Color fundus image
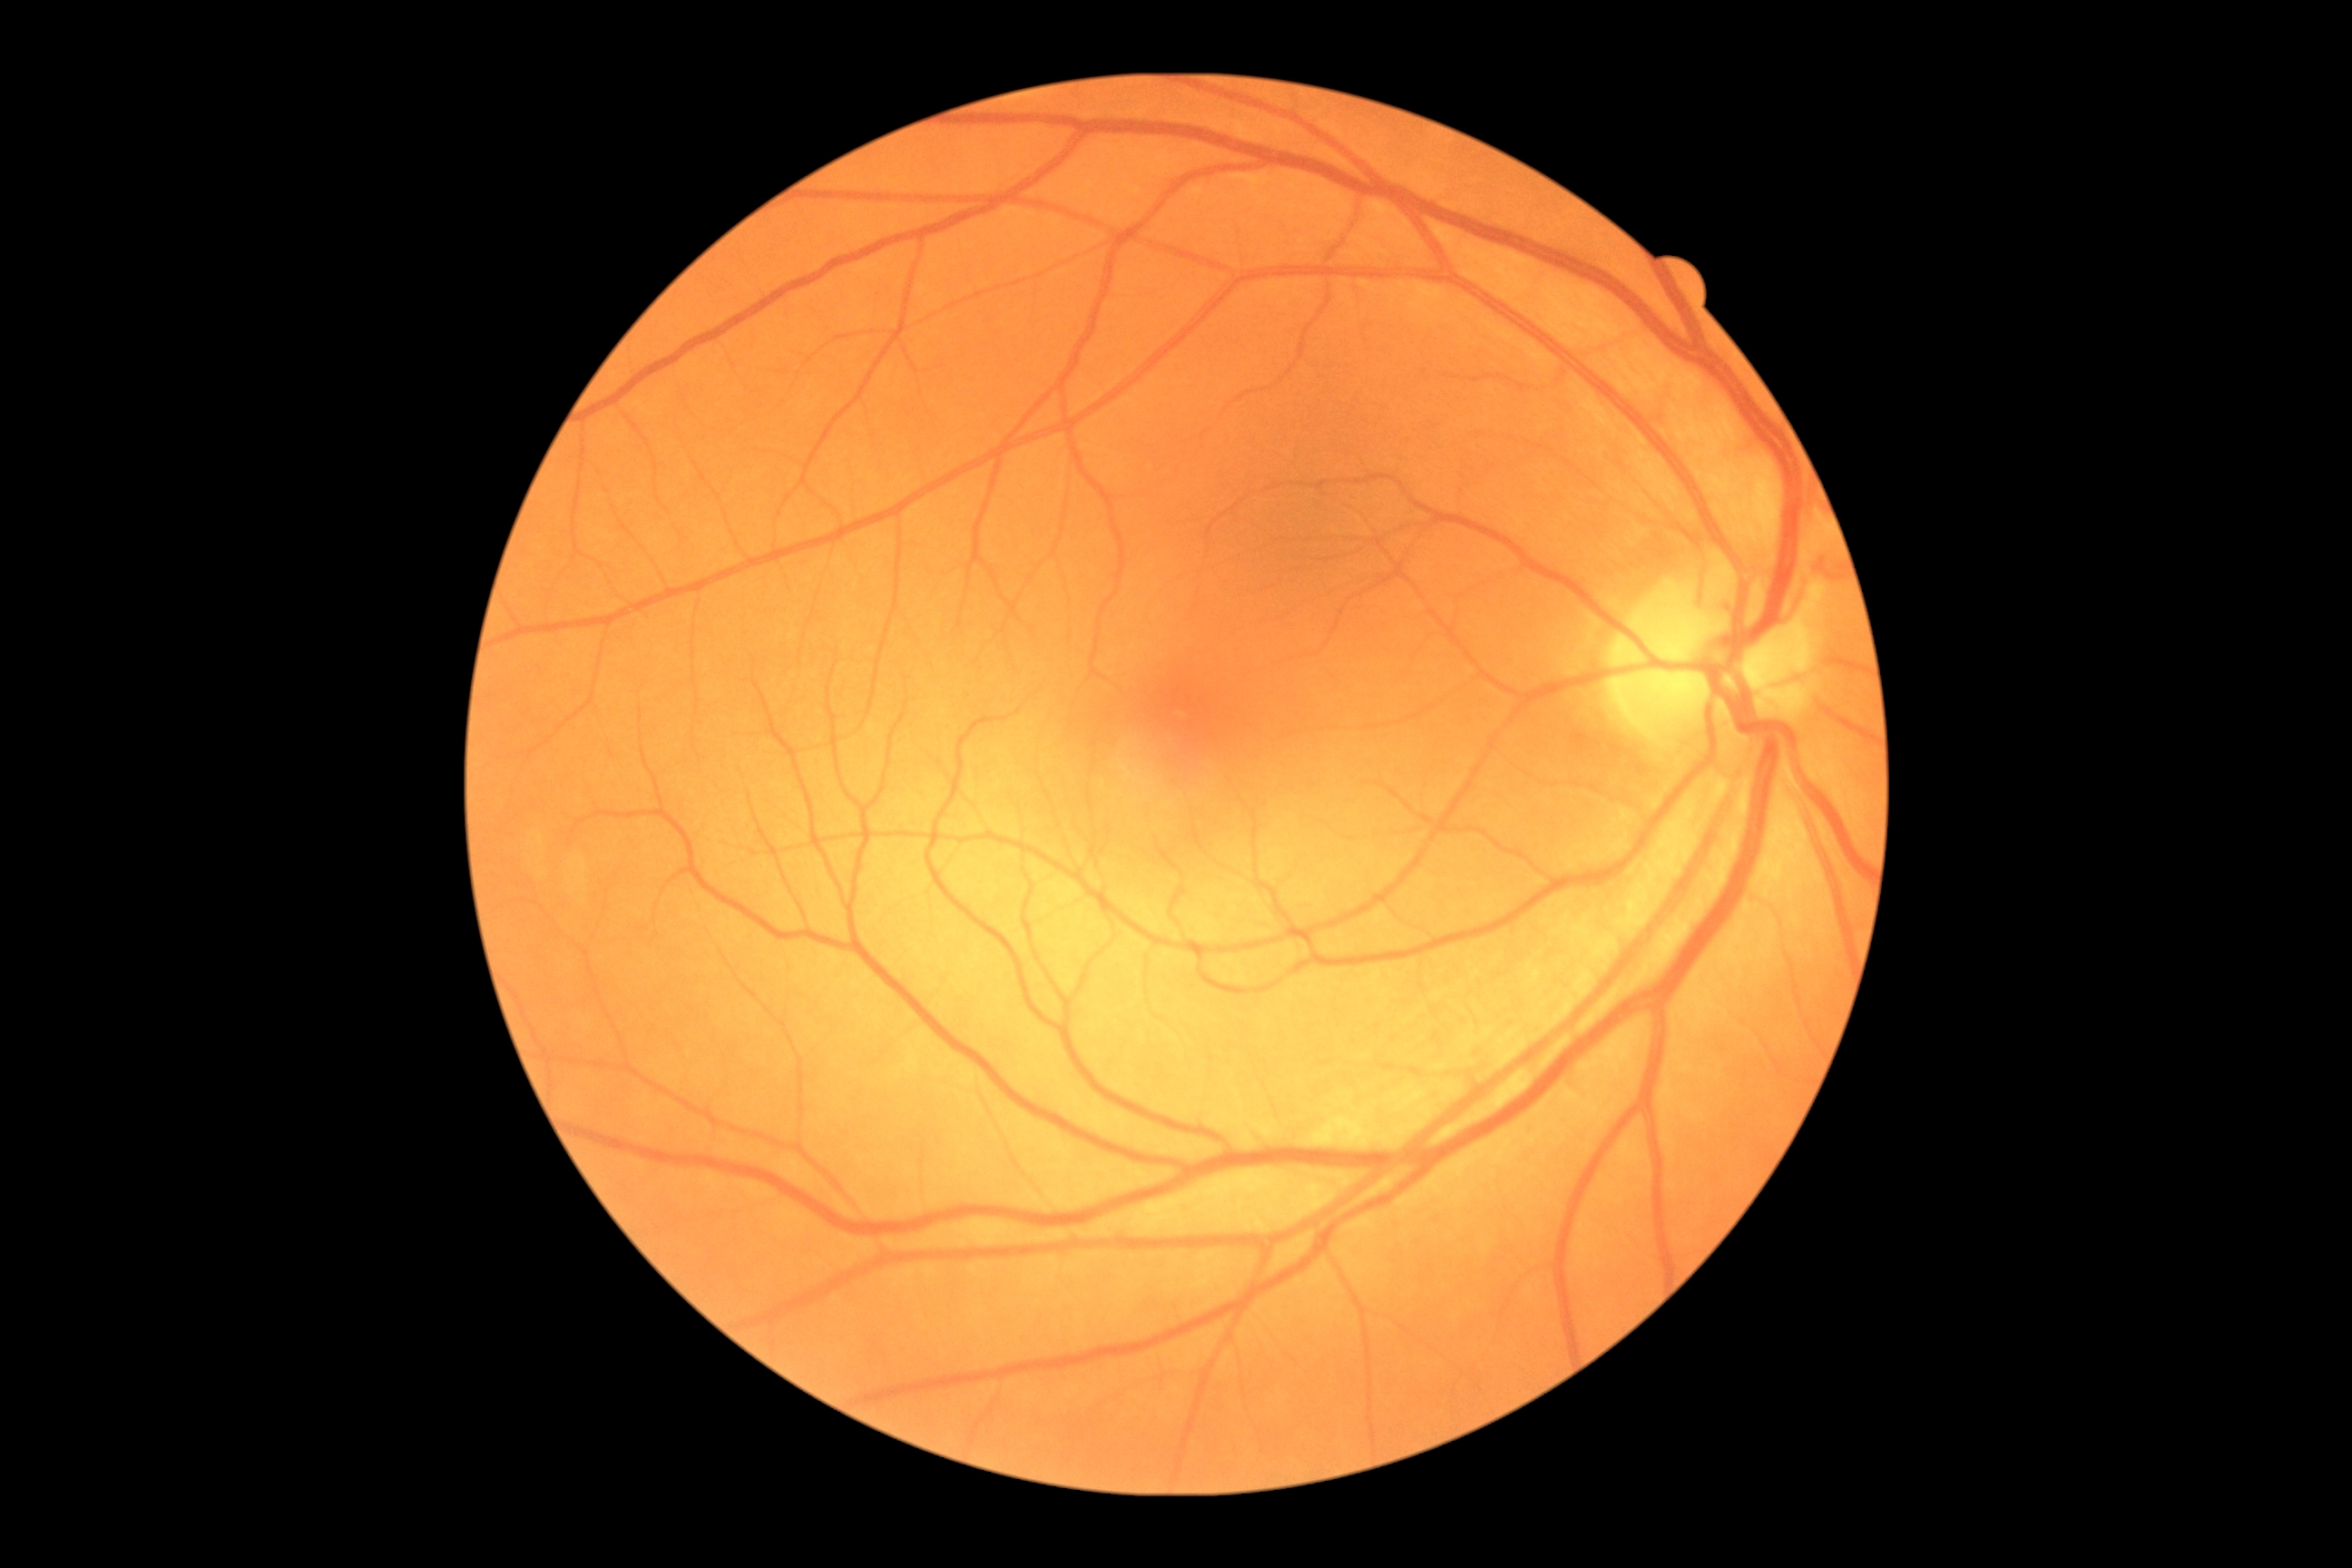   dr_grade: 0 — no visible signs of diabetic retinopathy